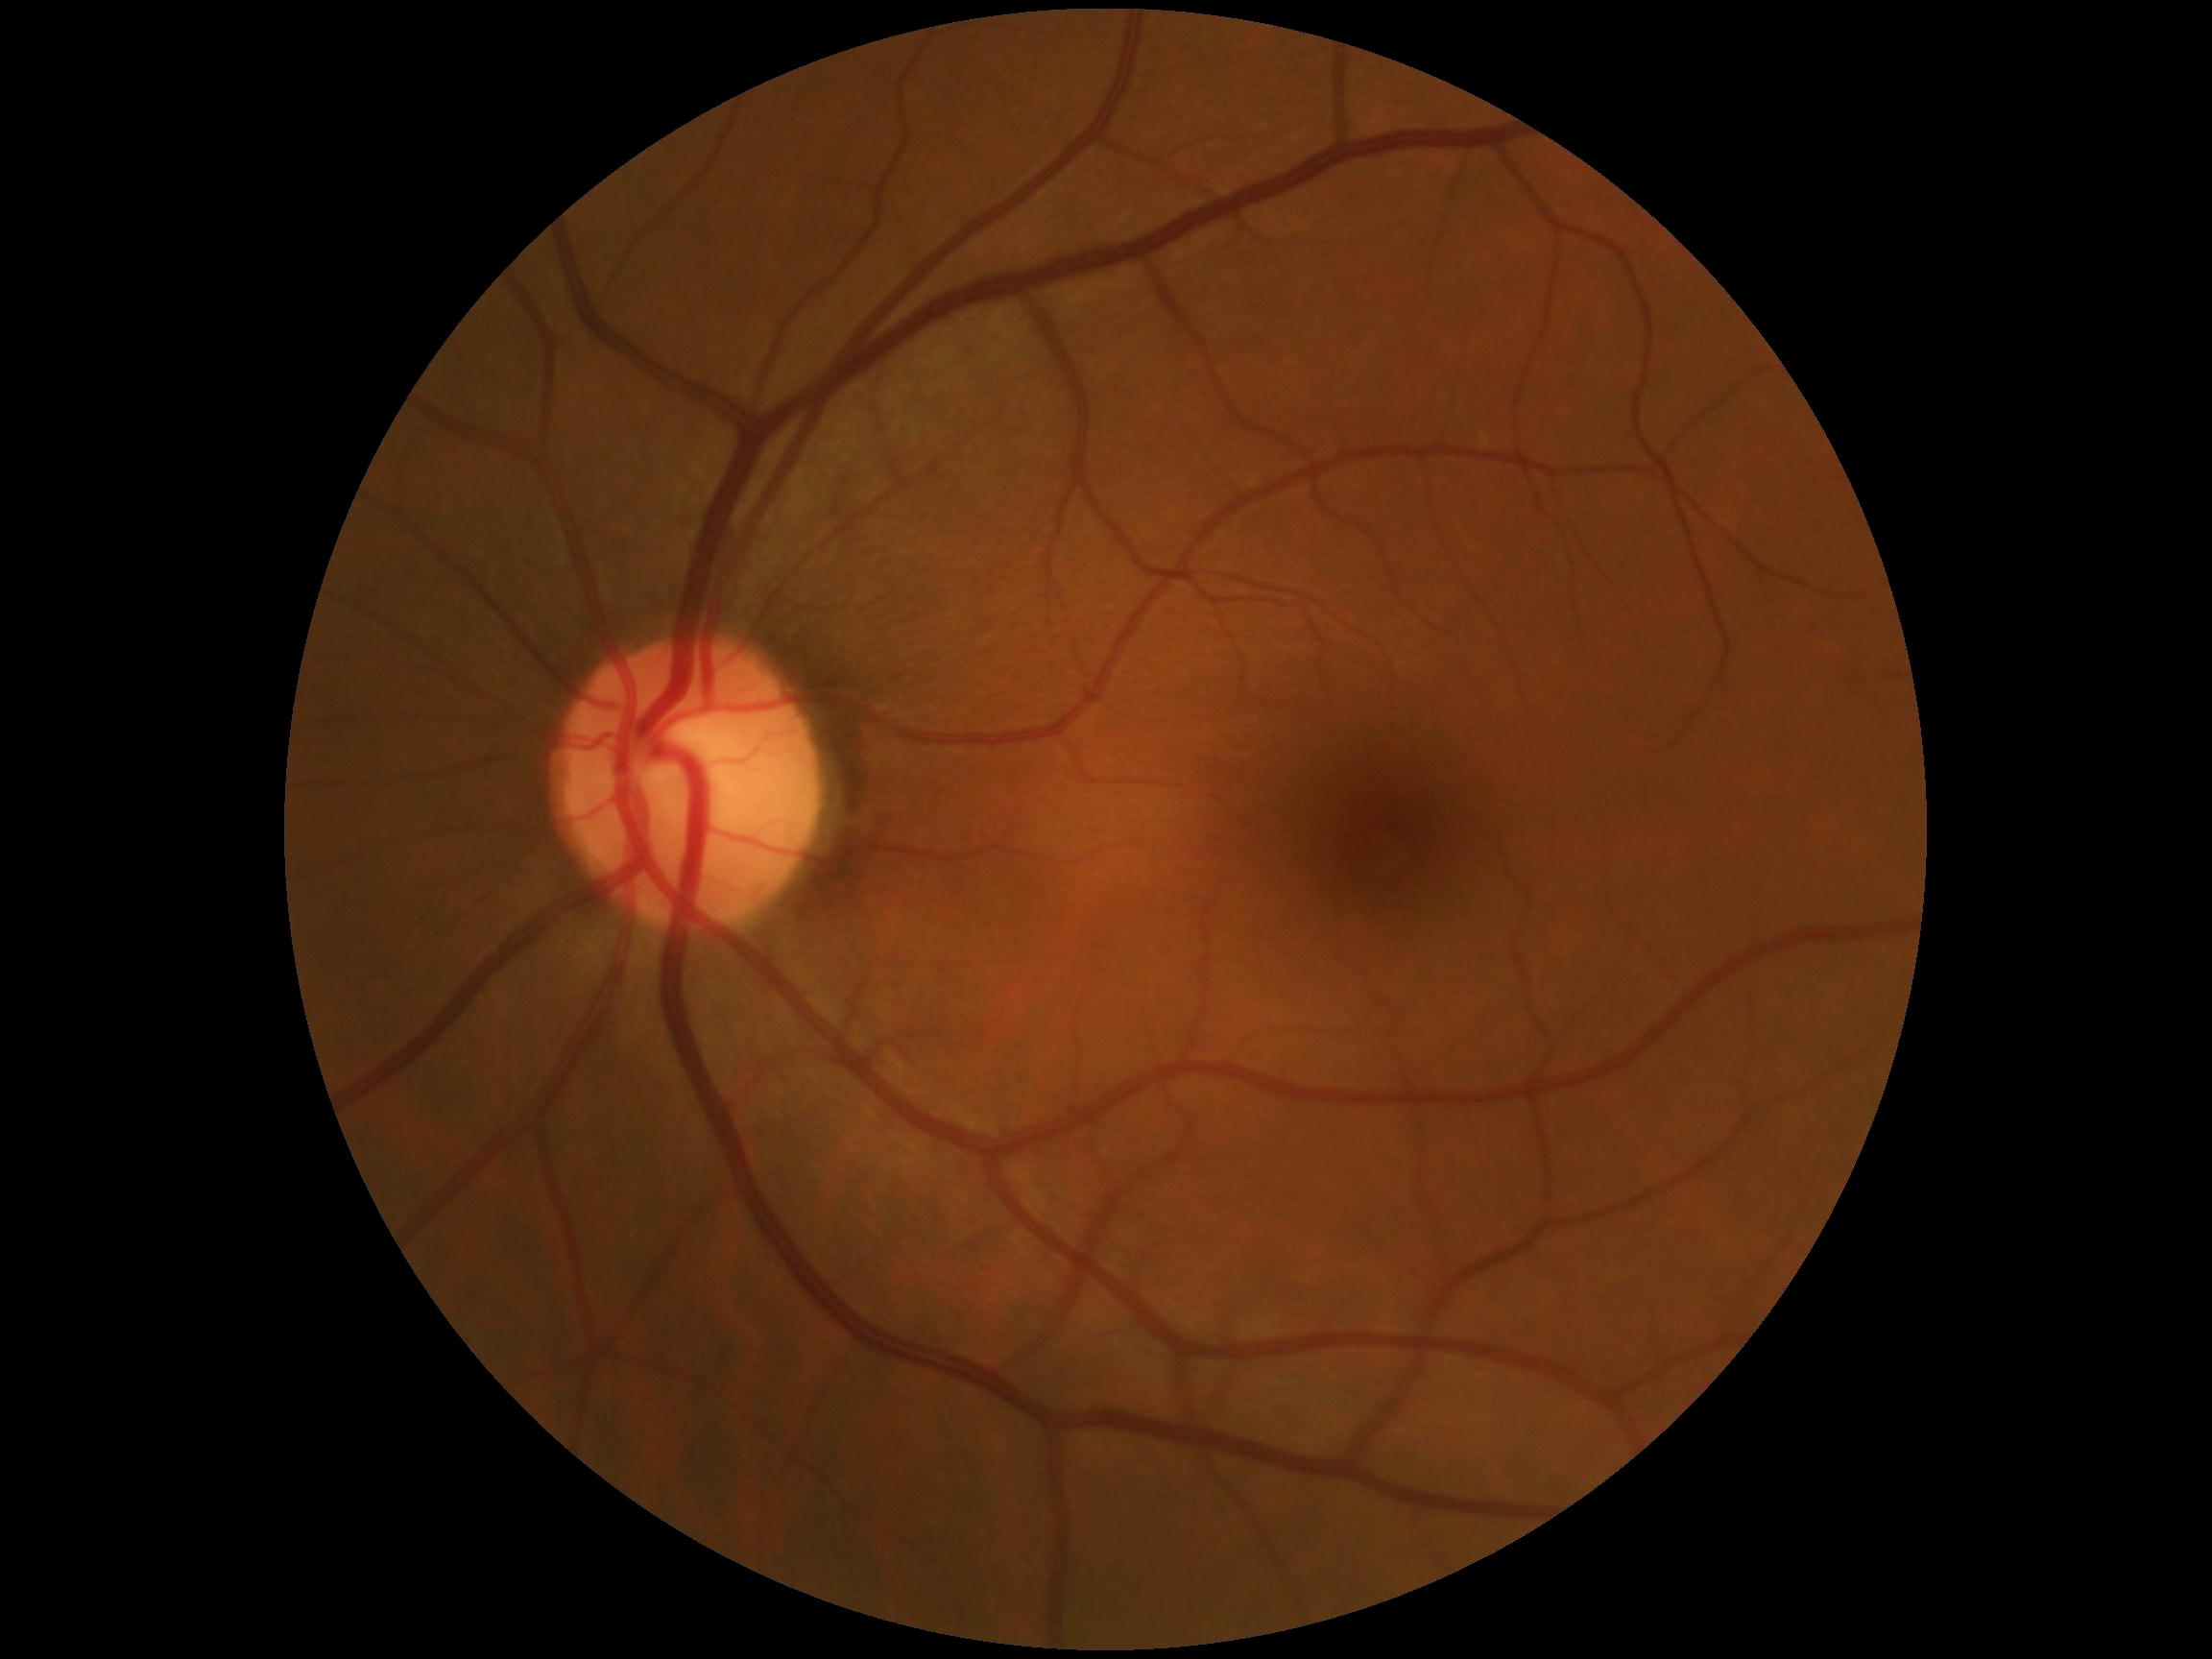 Annotations:
– diabetic retinopathy severity — grade 0 (no apparent retinopathy) — no visible signs of diabetic retinopathy